Fundus photo, FOV: 45 degrees:
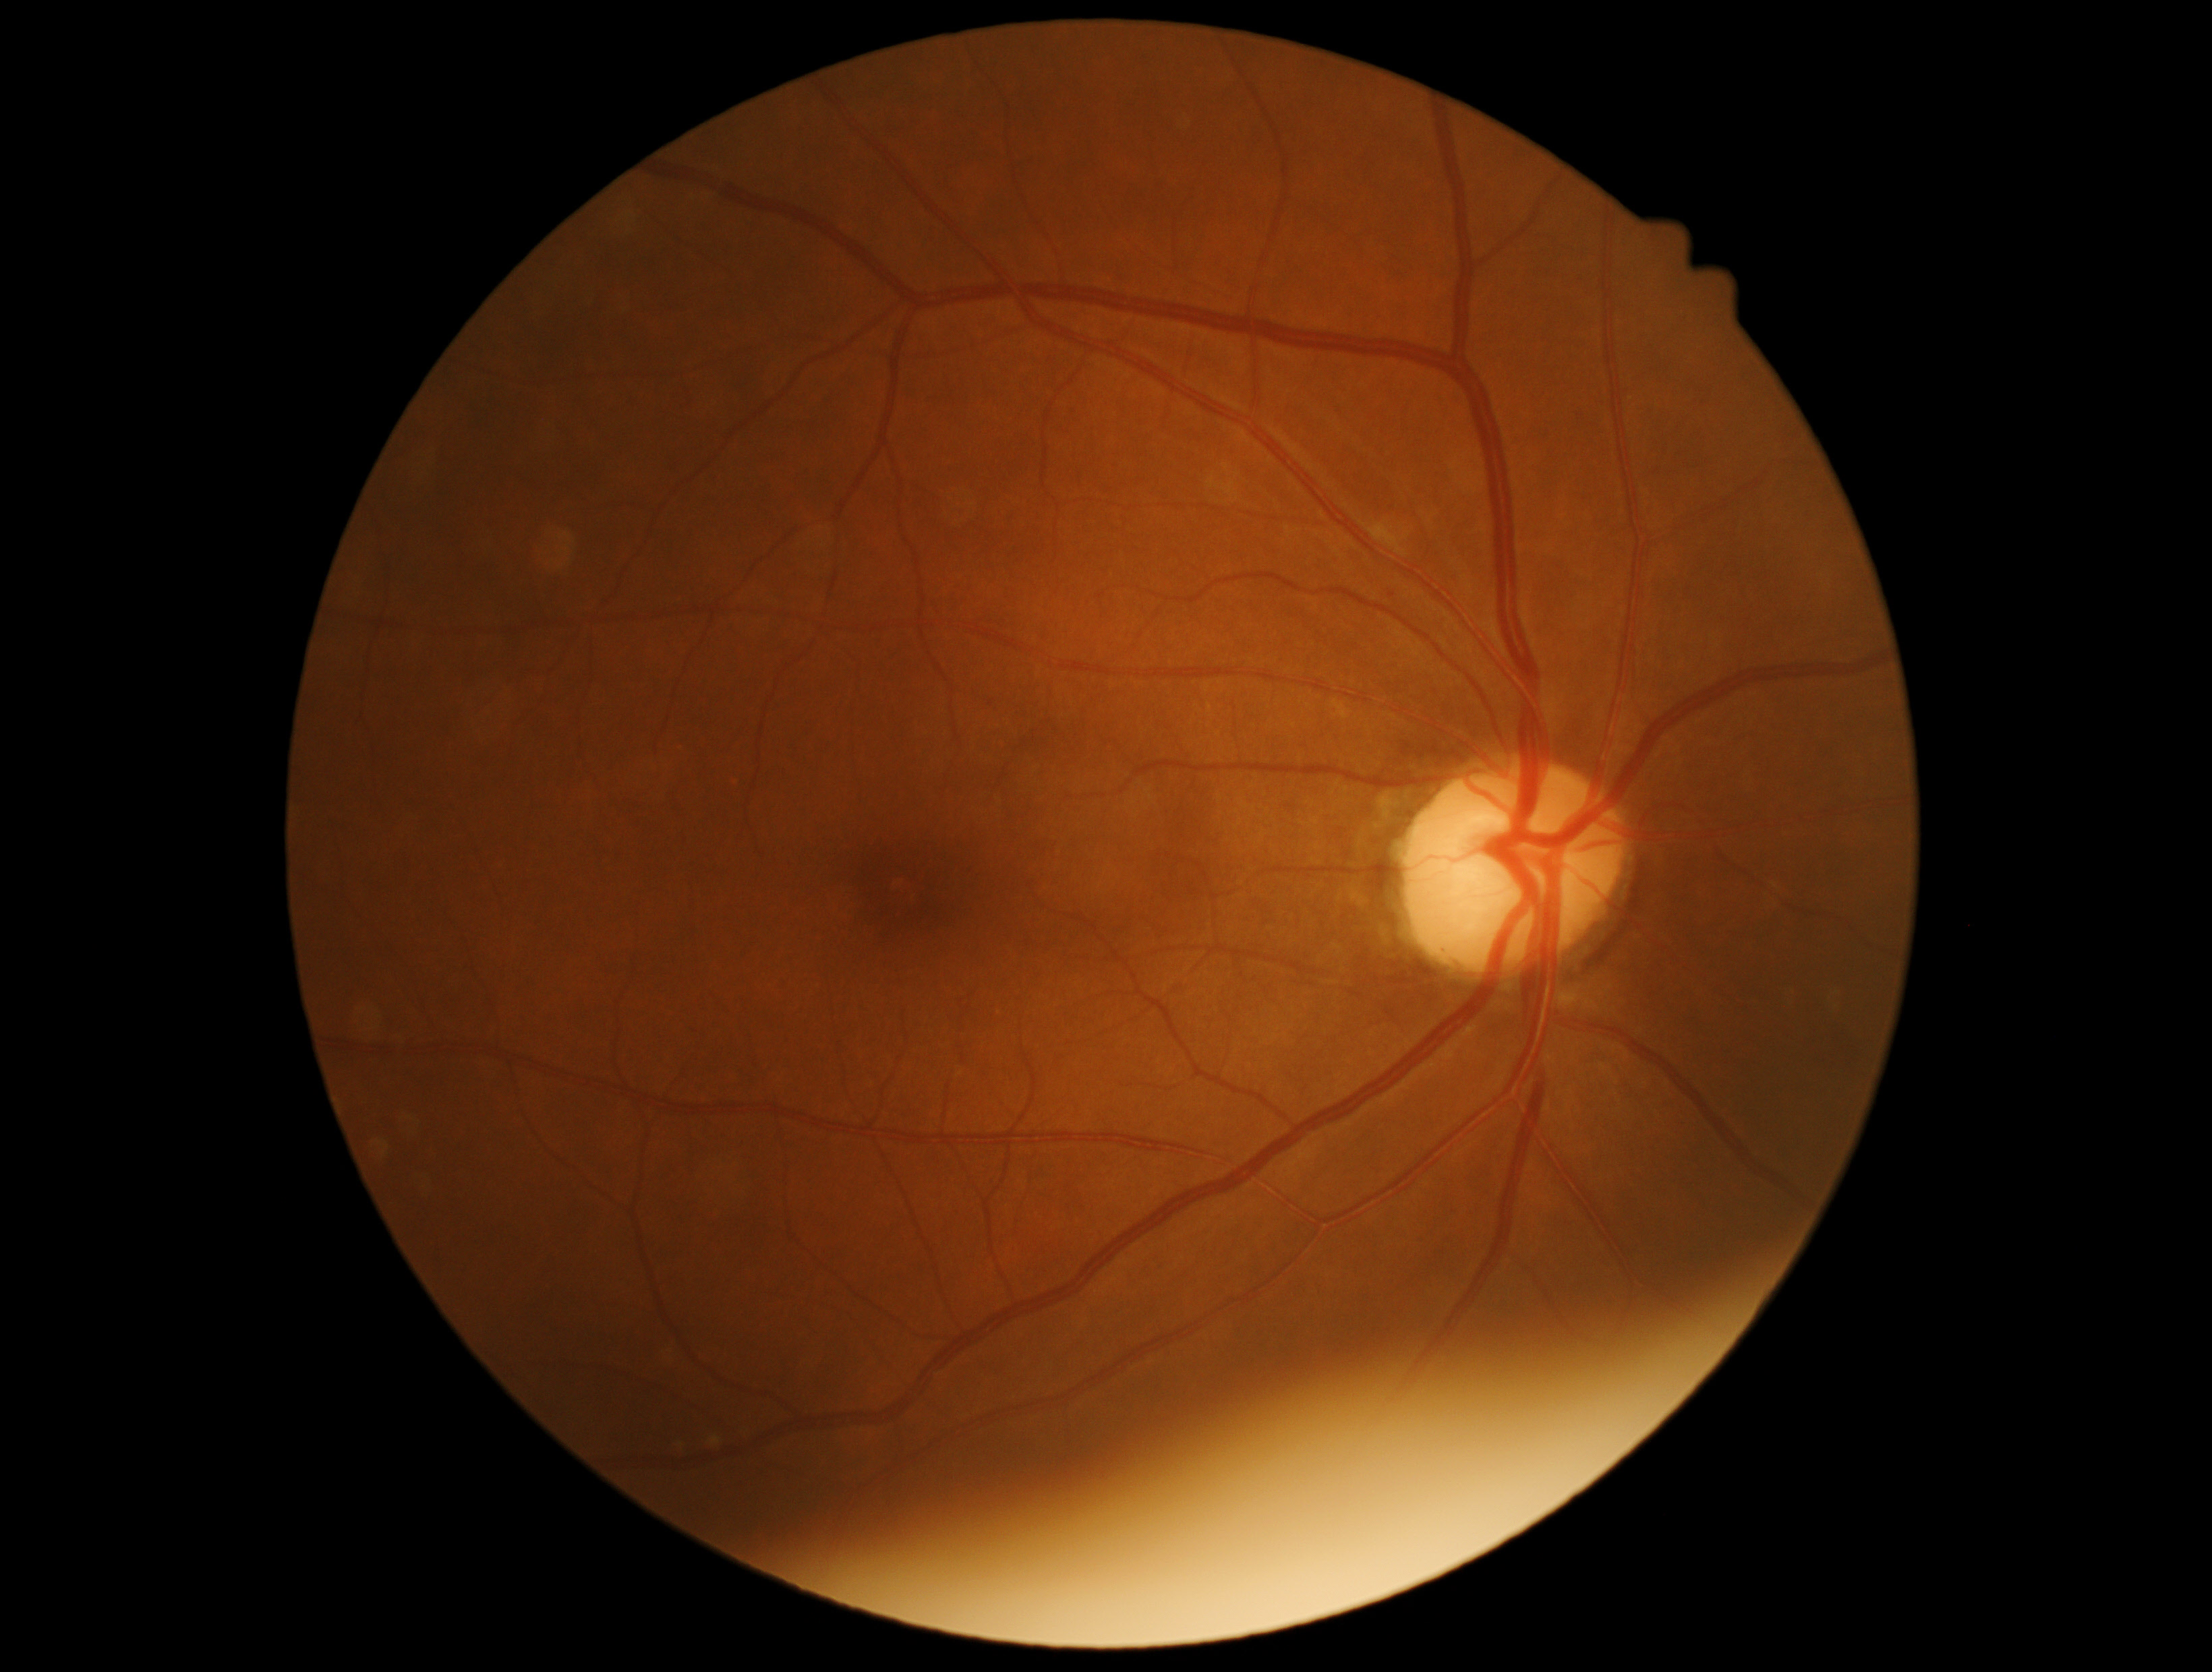 Findings:
- DR severity — 0/4